Color fundus image: 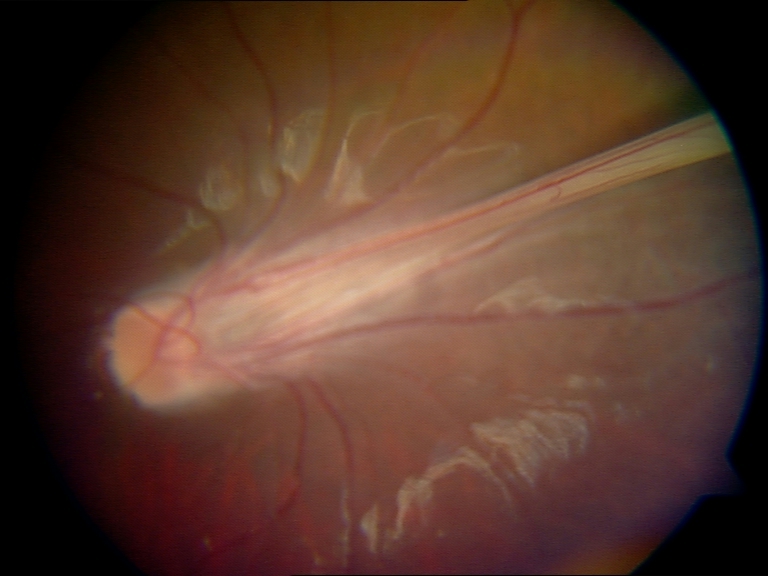

Findings: dragged disc.